2352x1568px · 45° field of view · retinal fundus photograph: 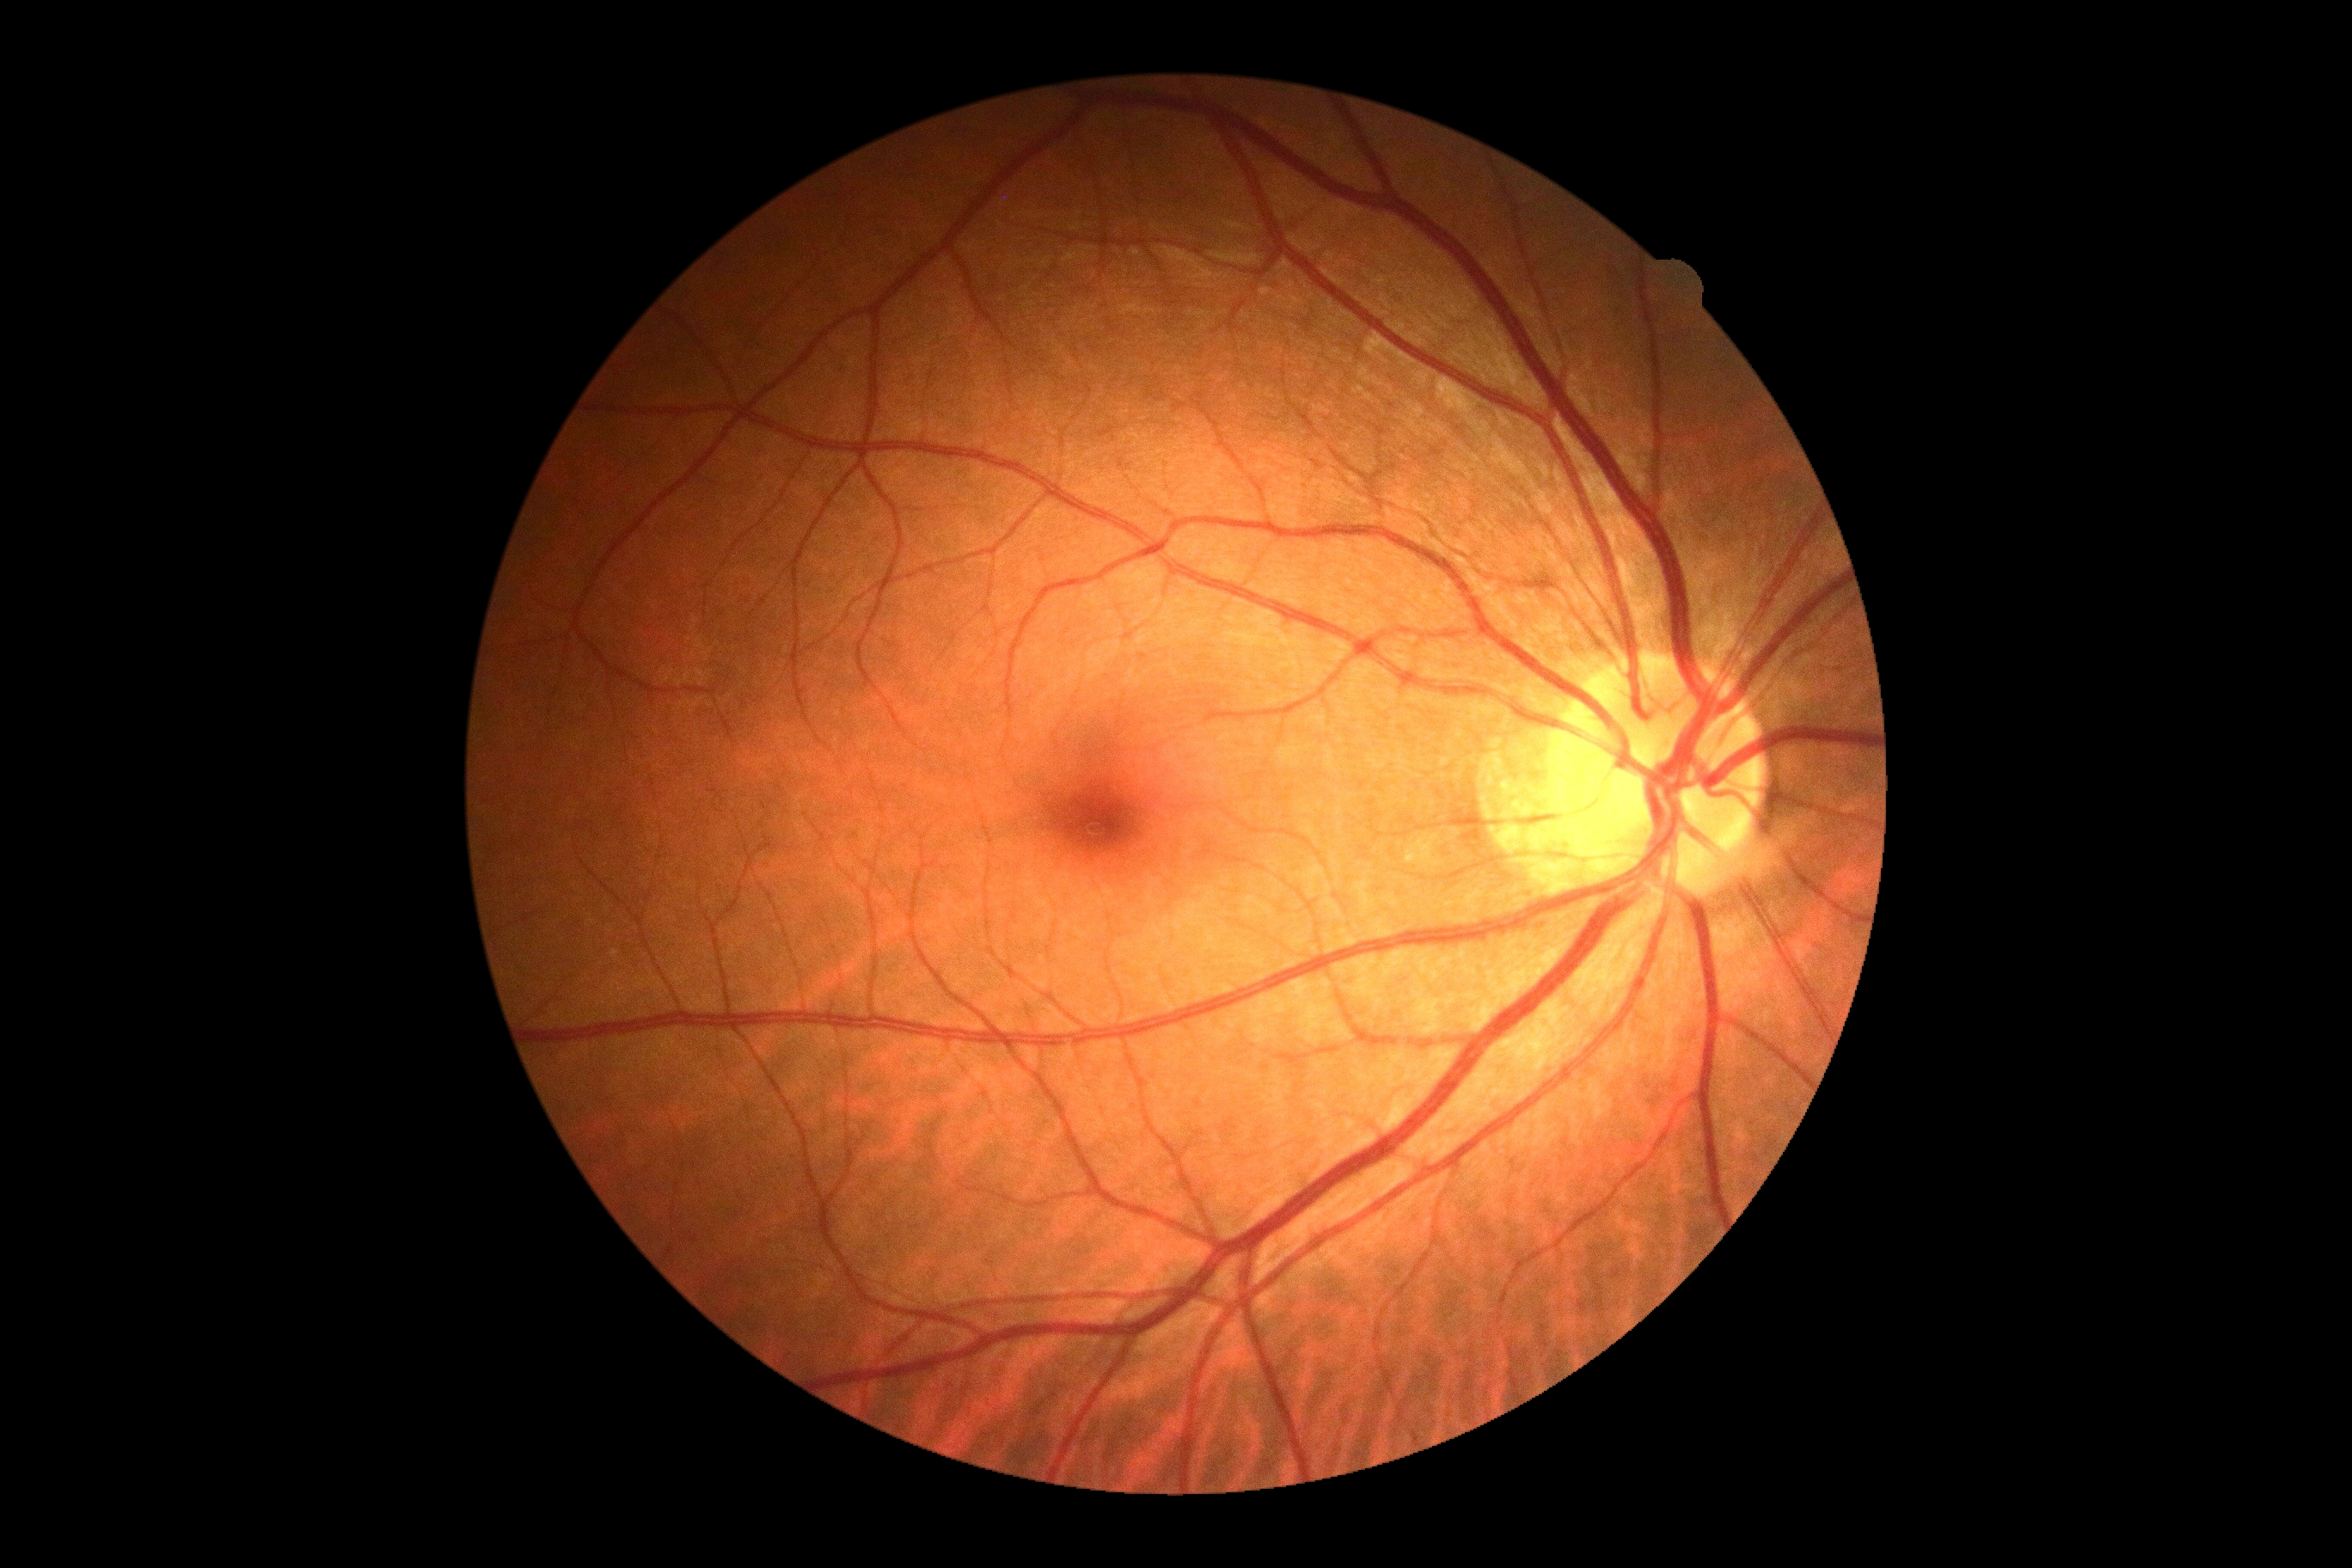
No diabetic retinal disease findings.
DR: no apparent retinopathy (grade 0) — no visible signs of diabetic retinopathy.